Camera: NIDEK AFC-230, diabetic retinopathy graded by the modified Davis classification, nonmydriatic fundus photograph — 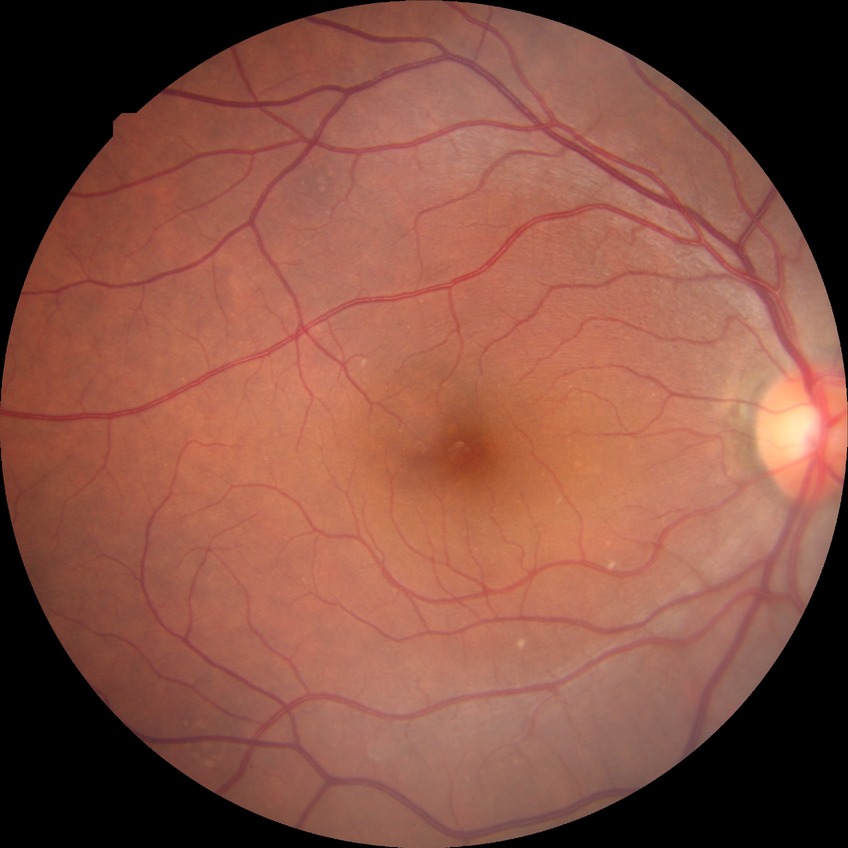

Diabetic retinopathy stage is no diabetic retinopathy.